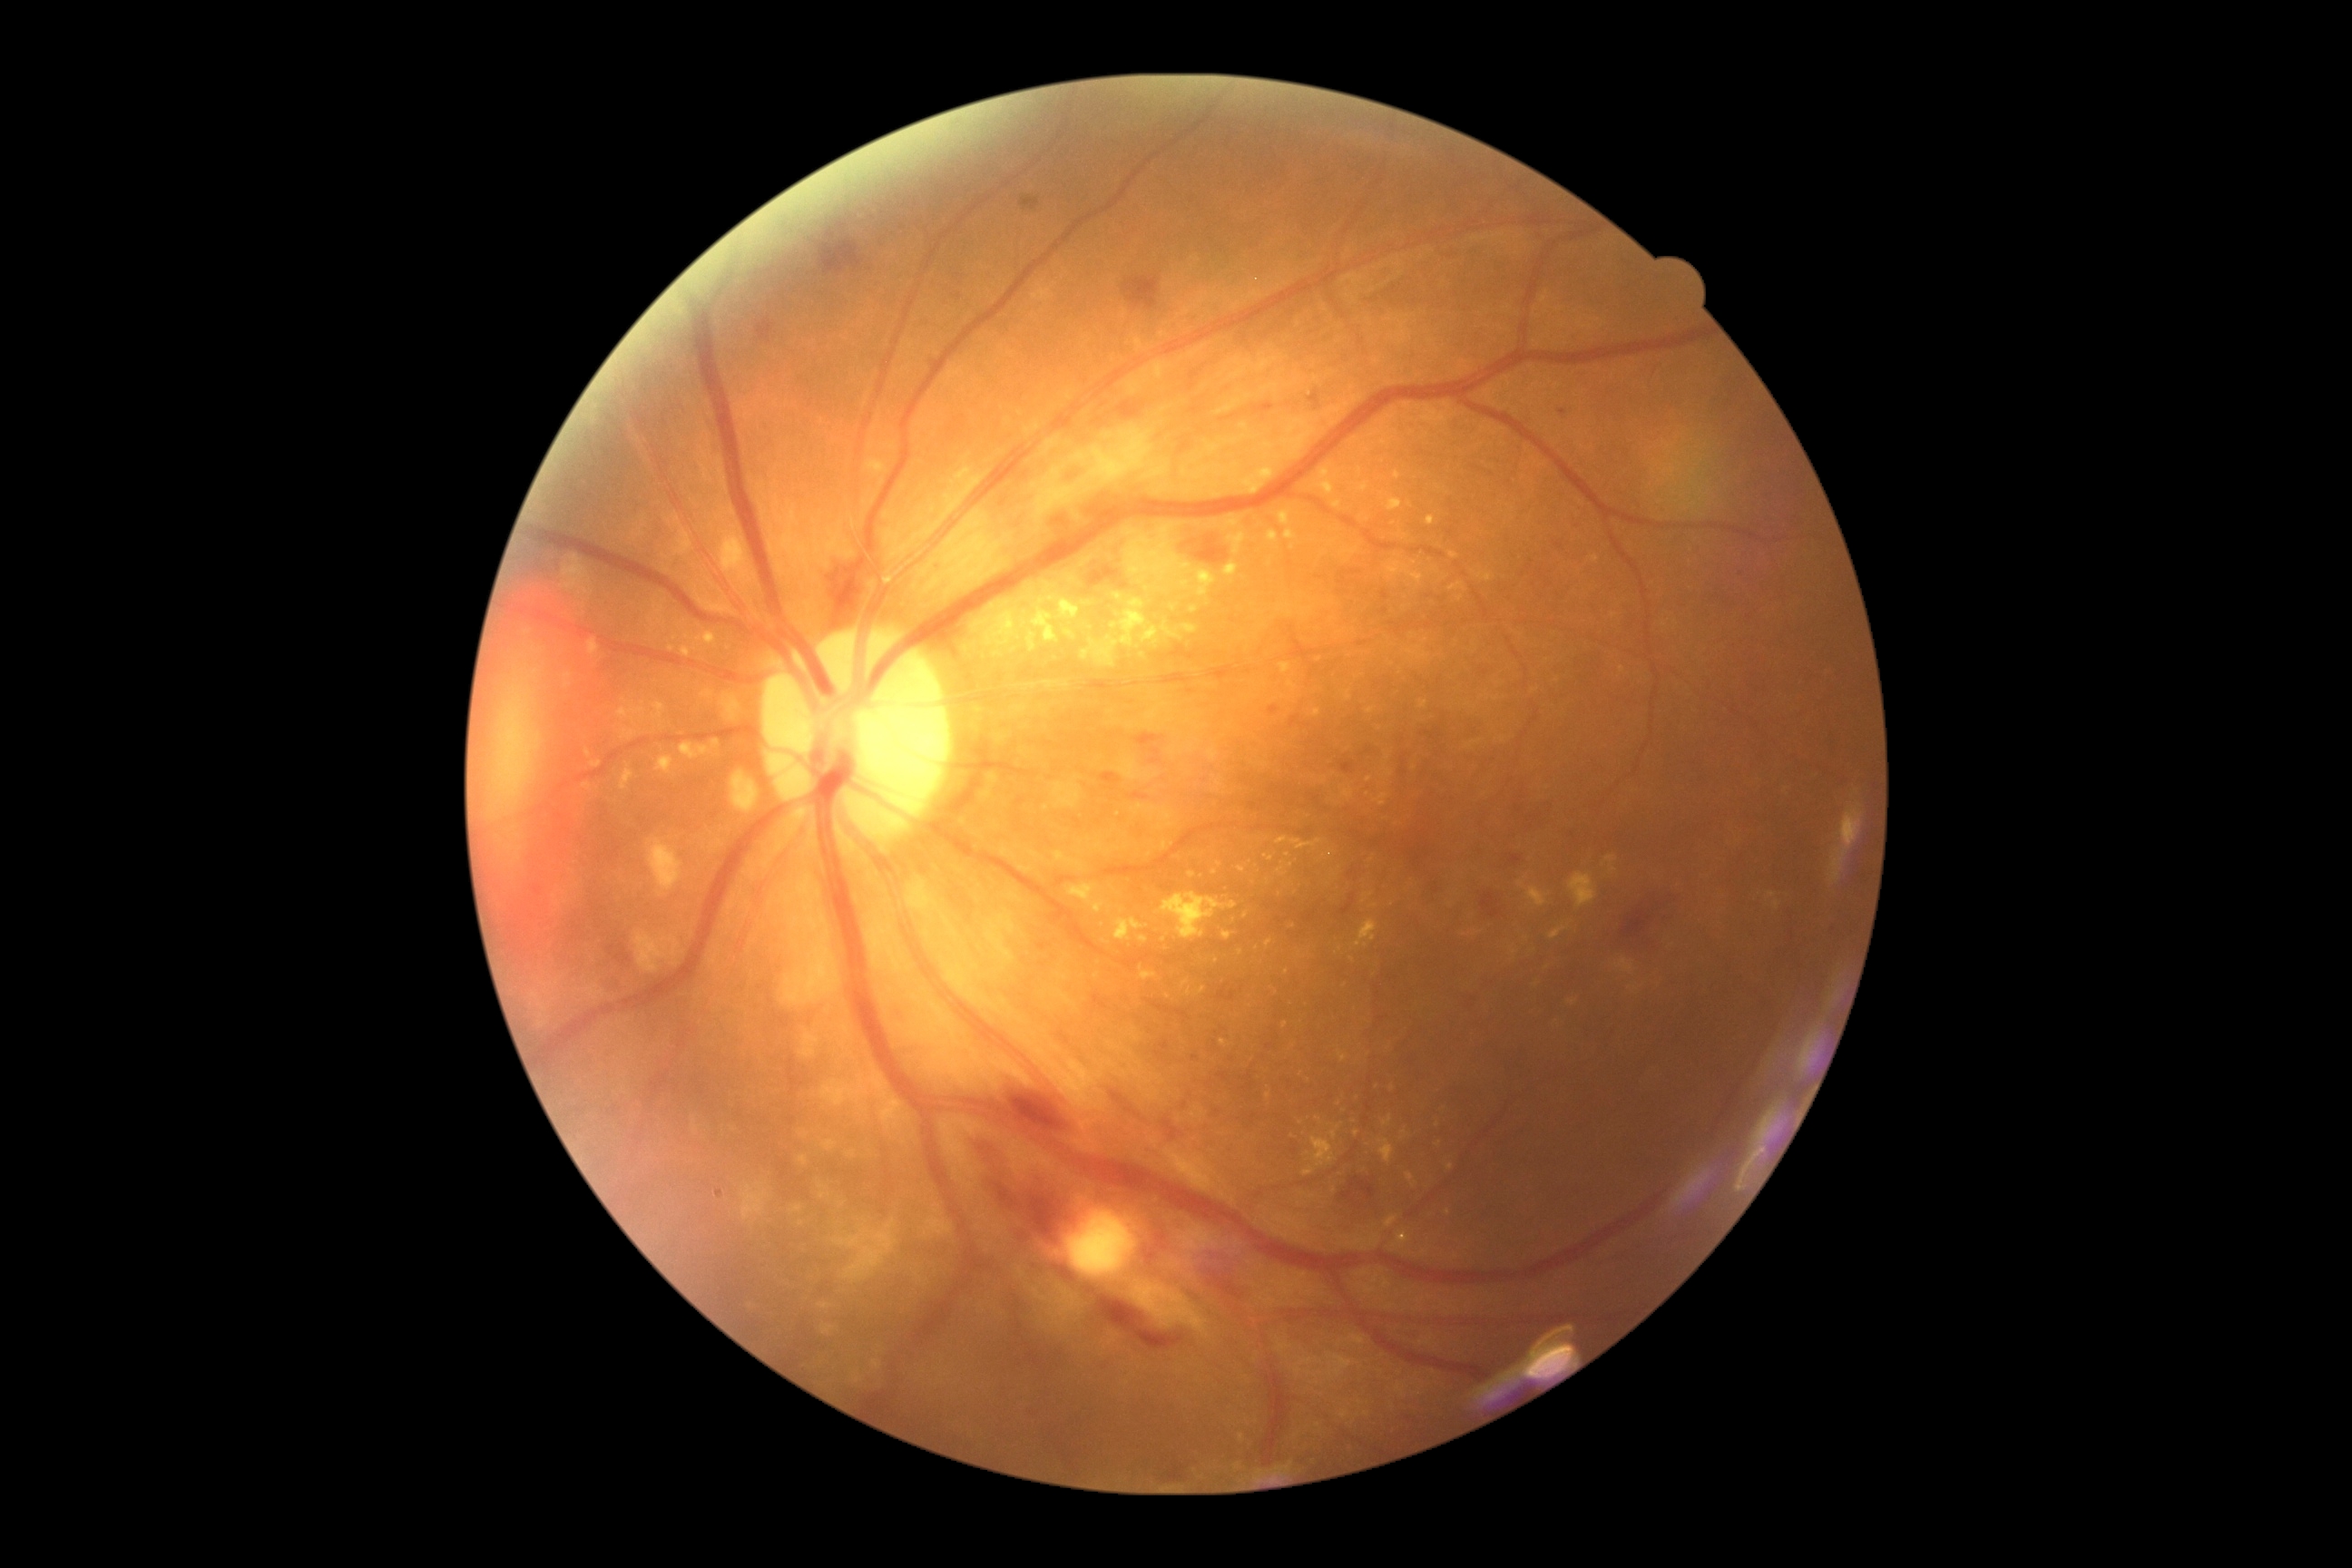
DR severity: grade 2 (moderate NPDR).